2048x1536.
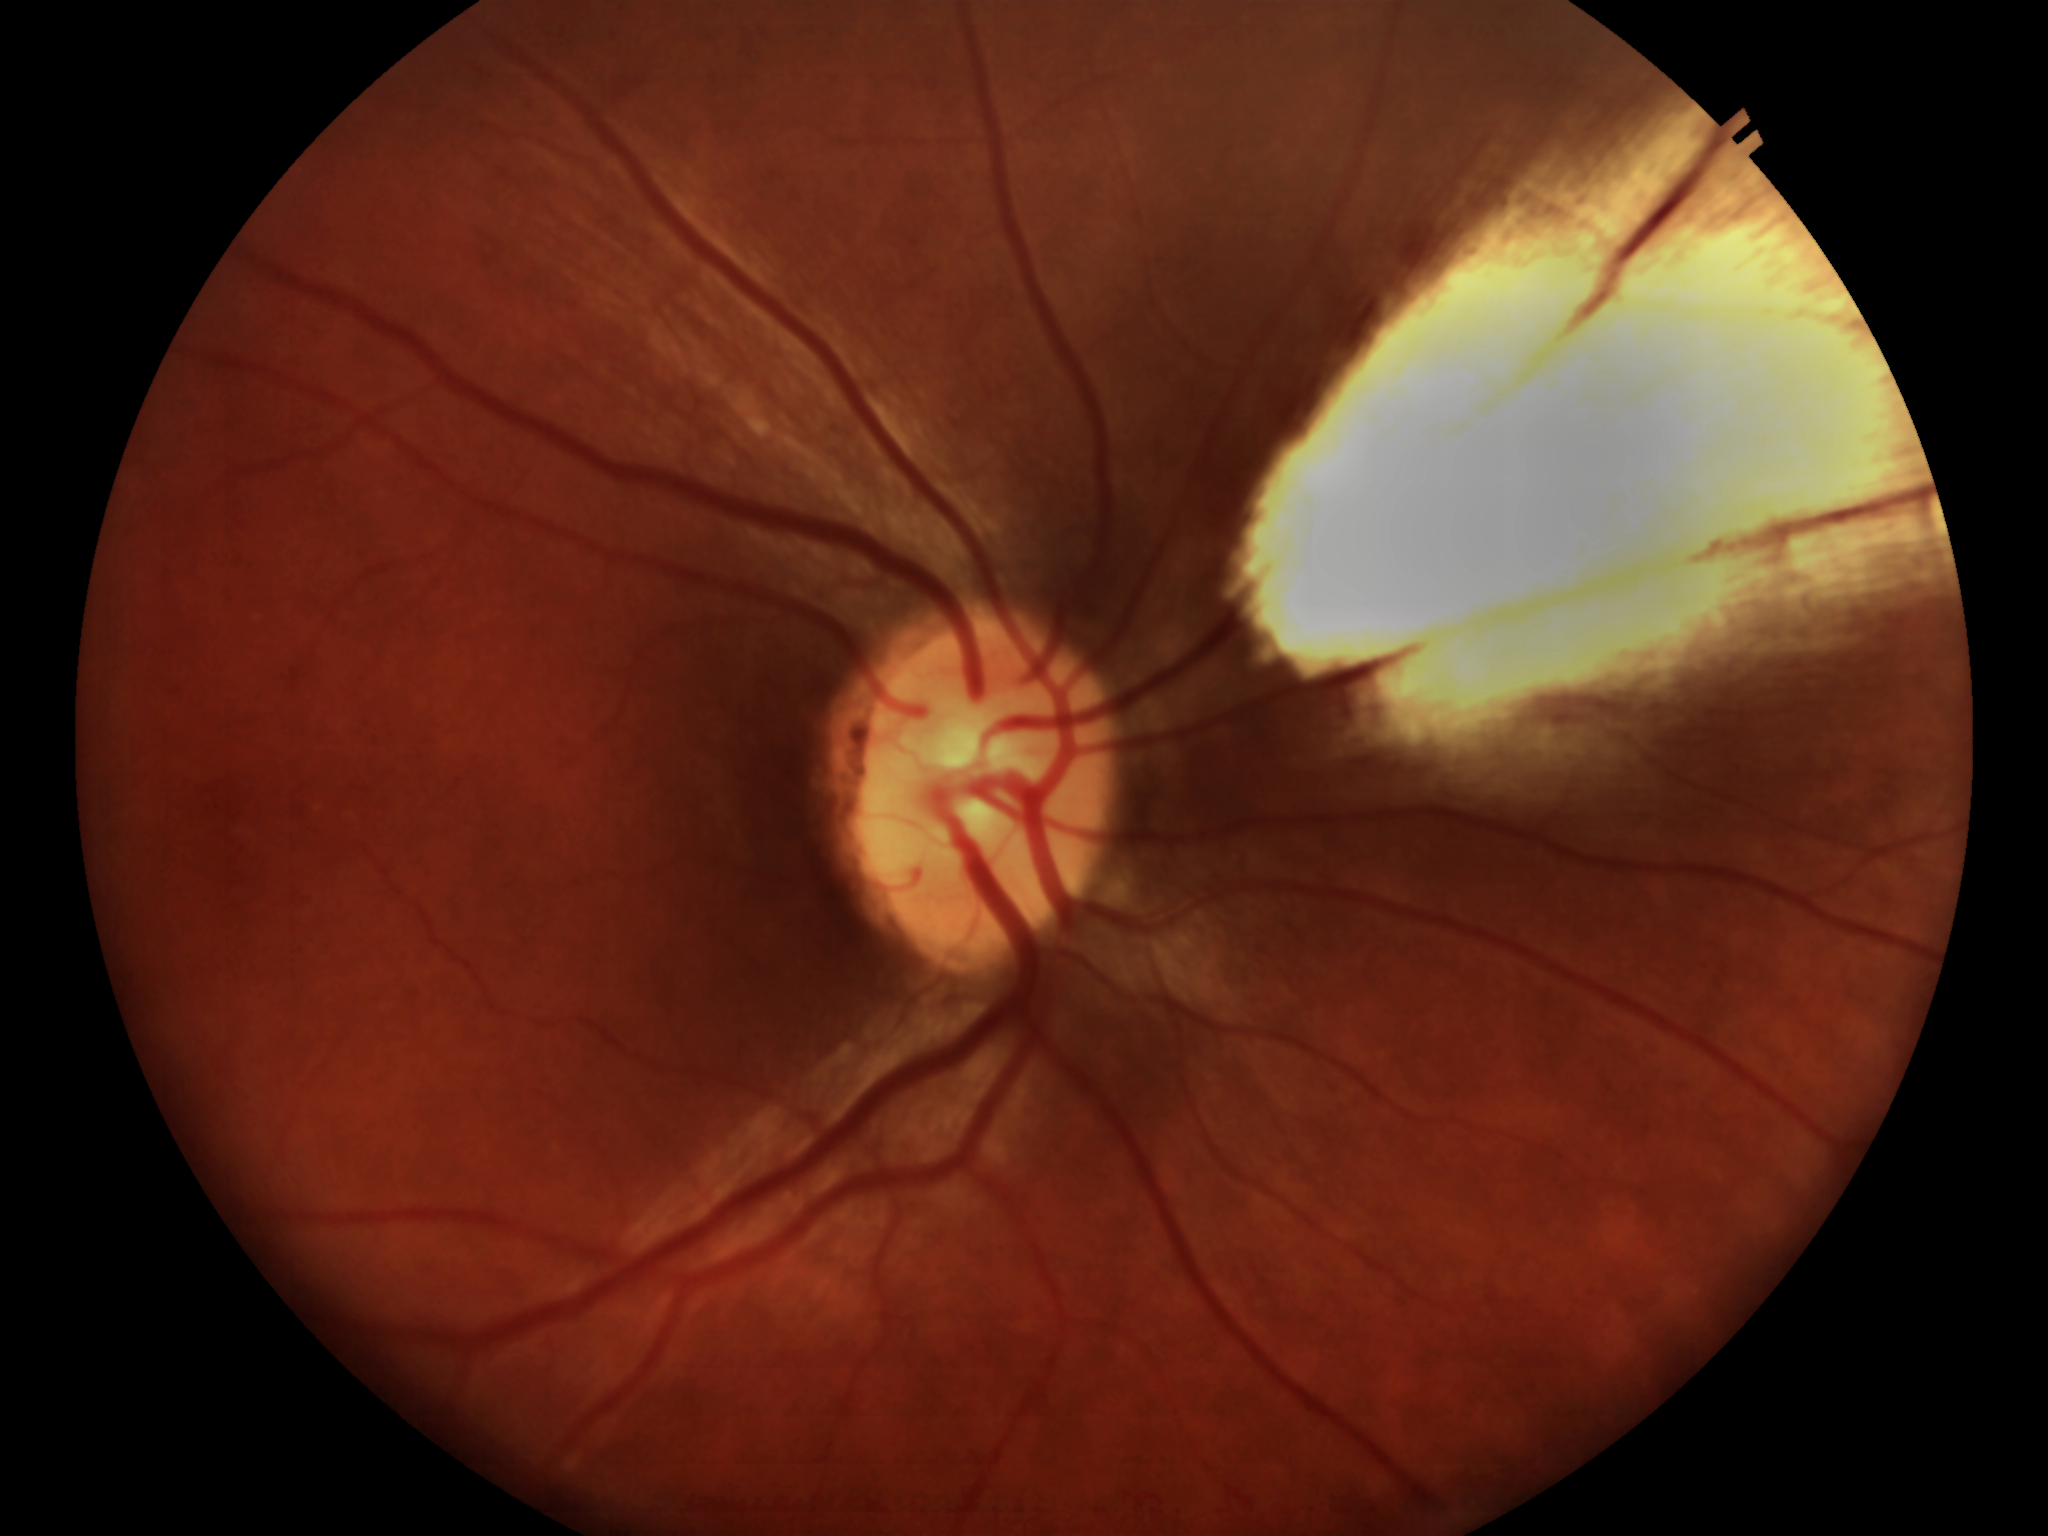

horizontal CDR: 0.51, vertical C/D ratio: 0.52, Glaucoma screening: negative (5/5 ophthalmologists in agreement).